Non-mydriatic: 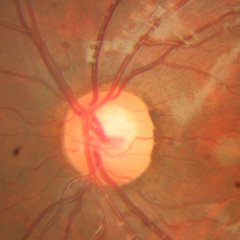

Q: Is glaucoma present?
A: No — no glaucomatous changes.